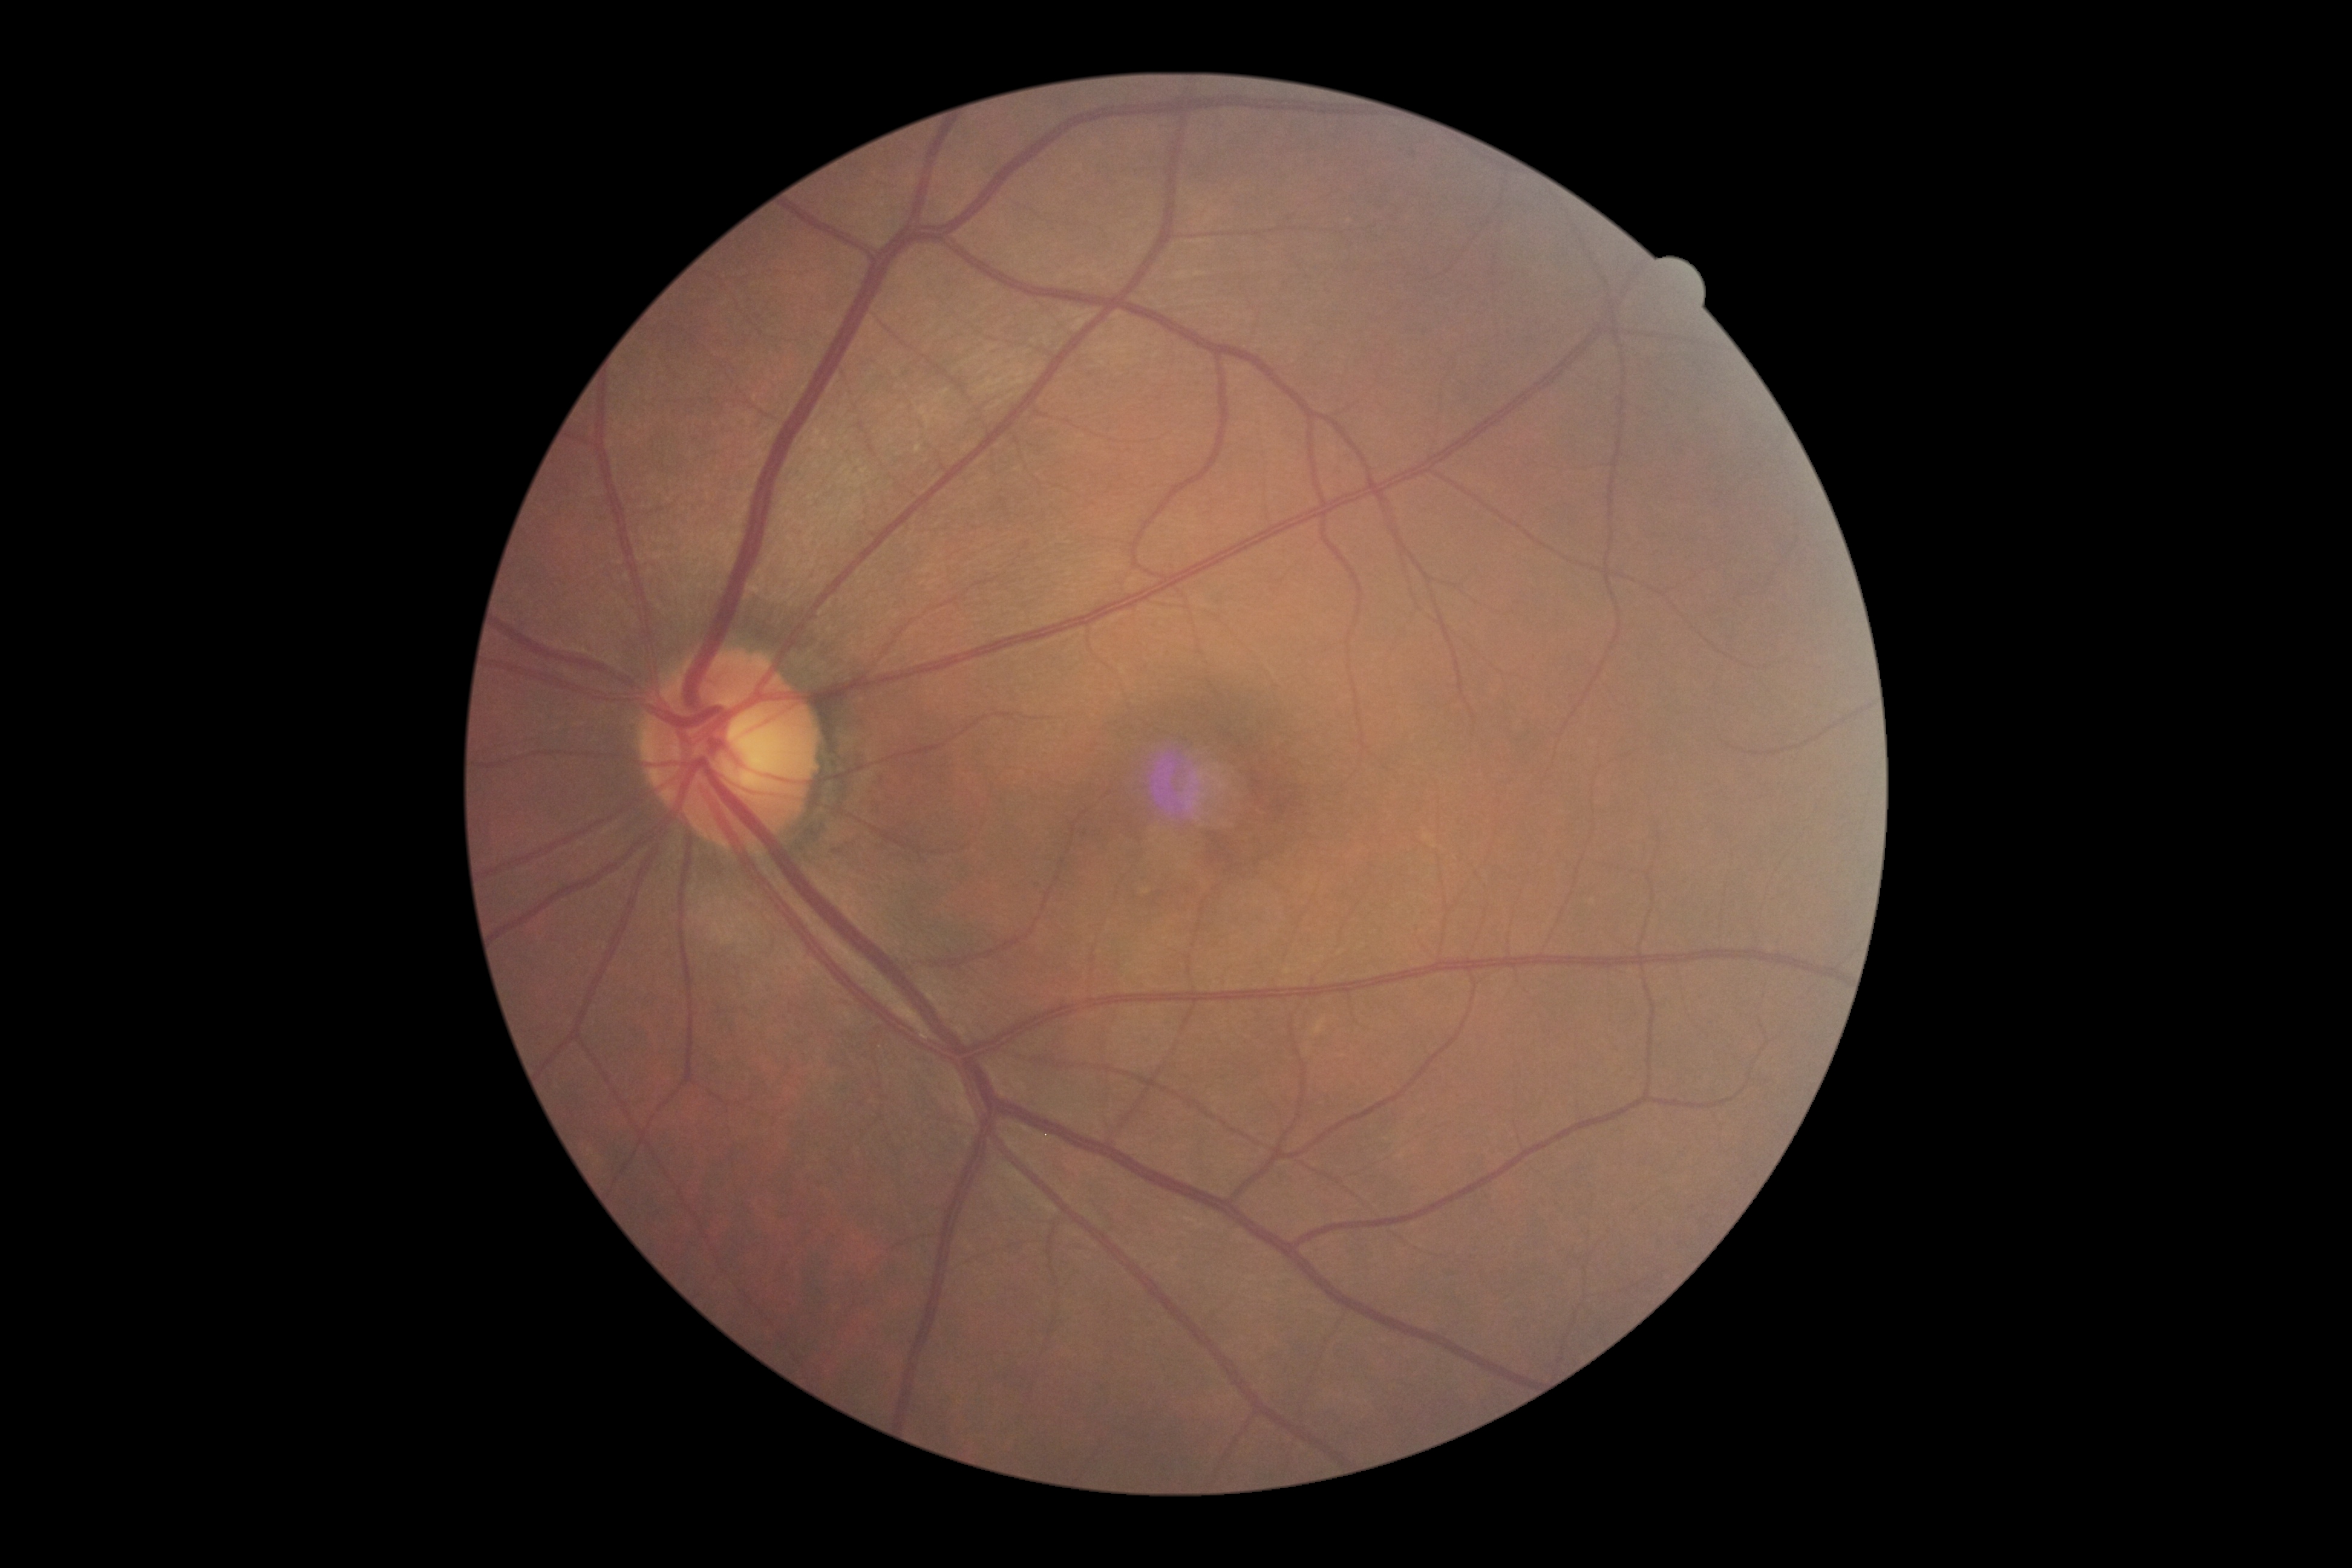 DR grade is 0 (no apparent retinopathy) — no visible signs of diabetic retinopathy. No diabetic retinal disease findings.